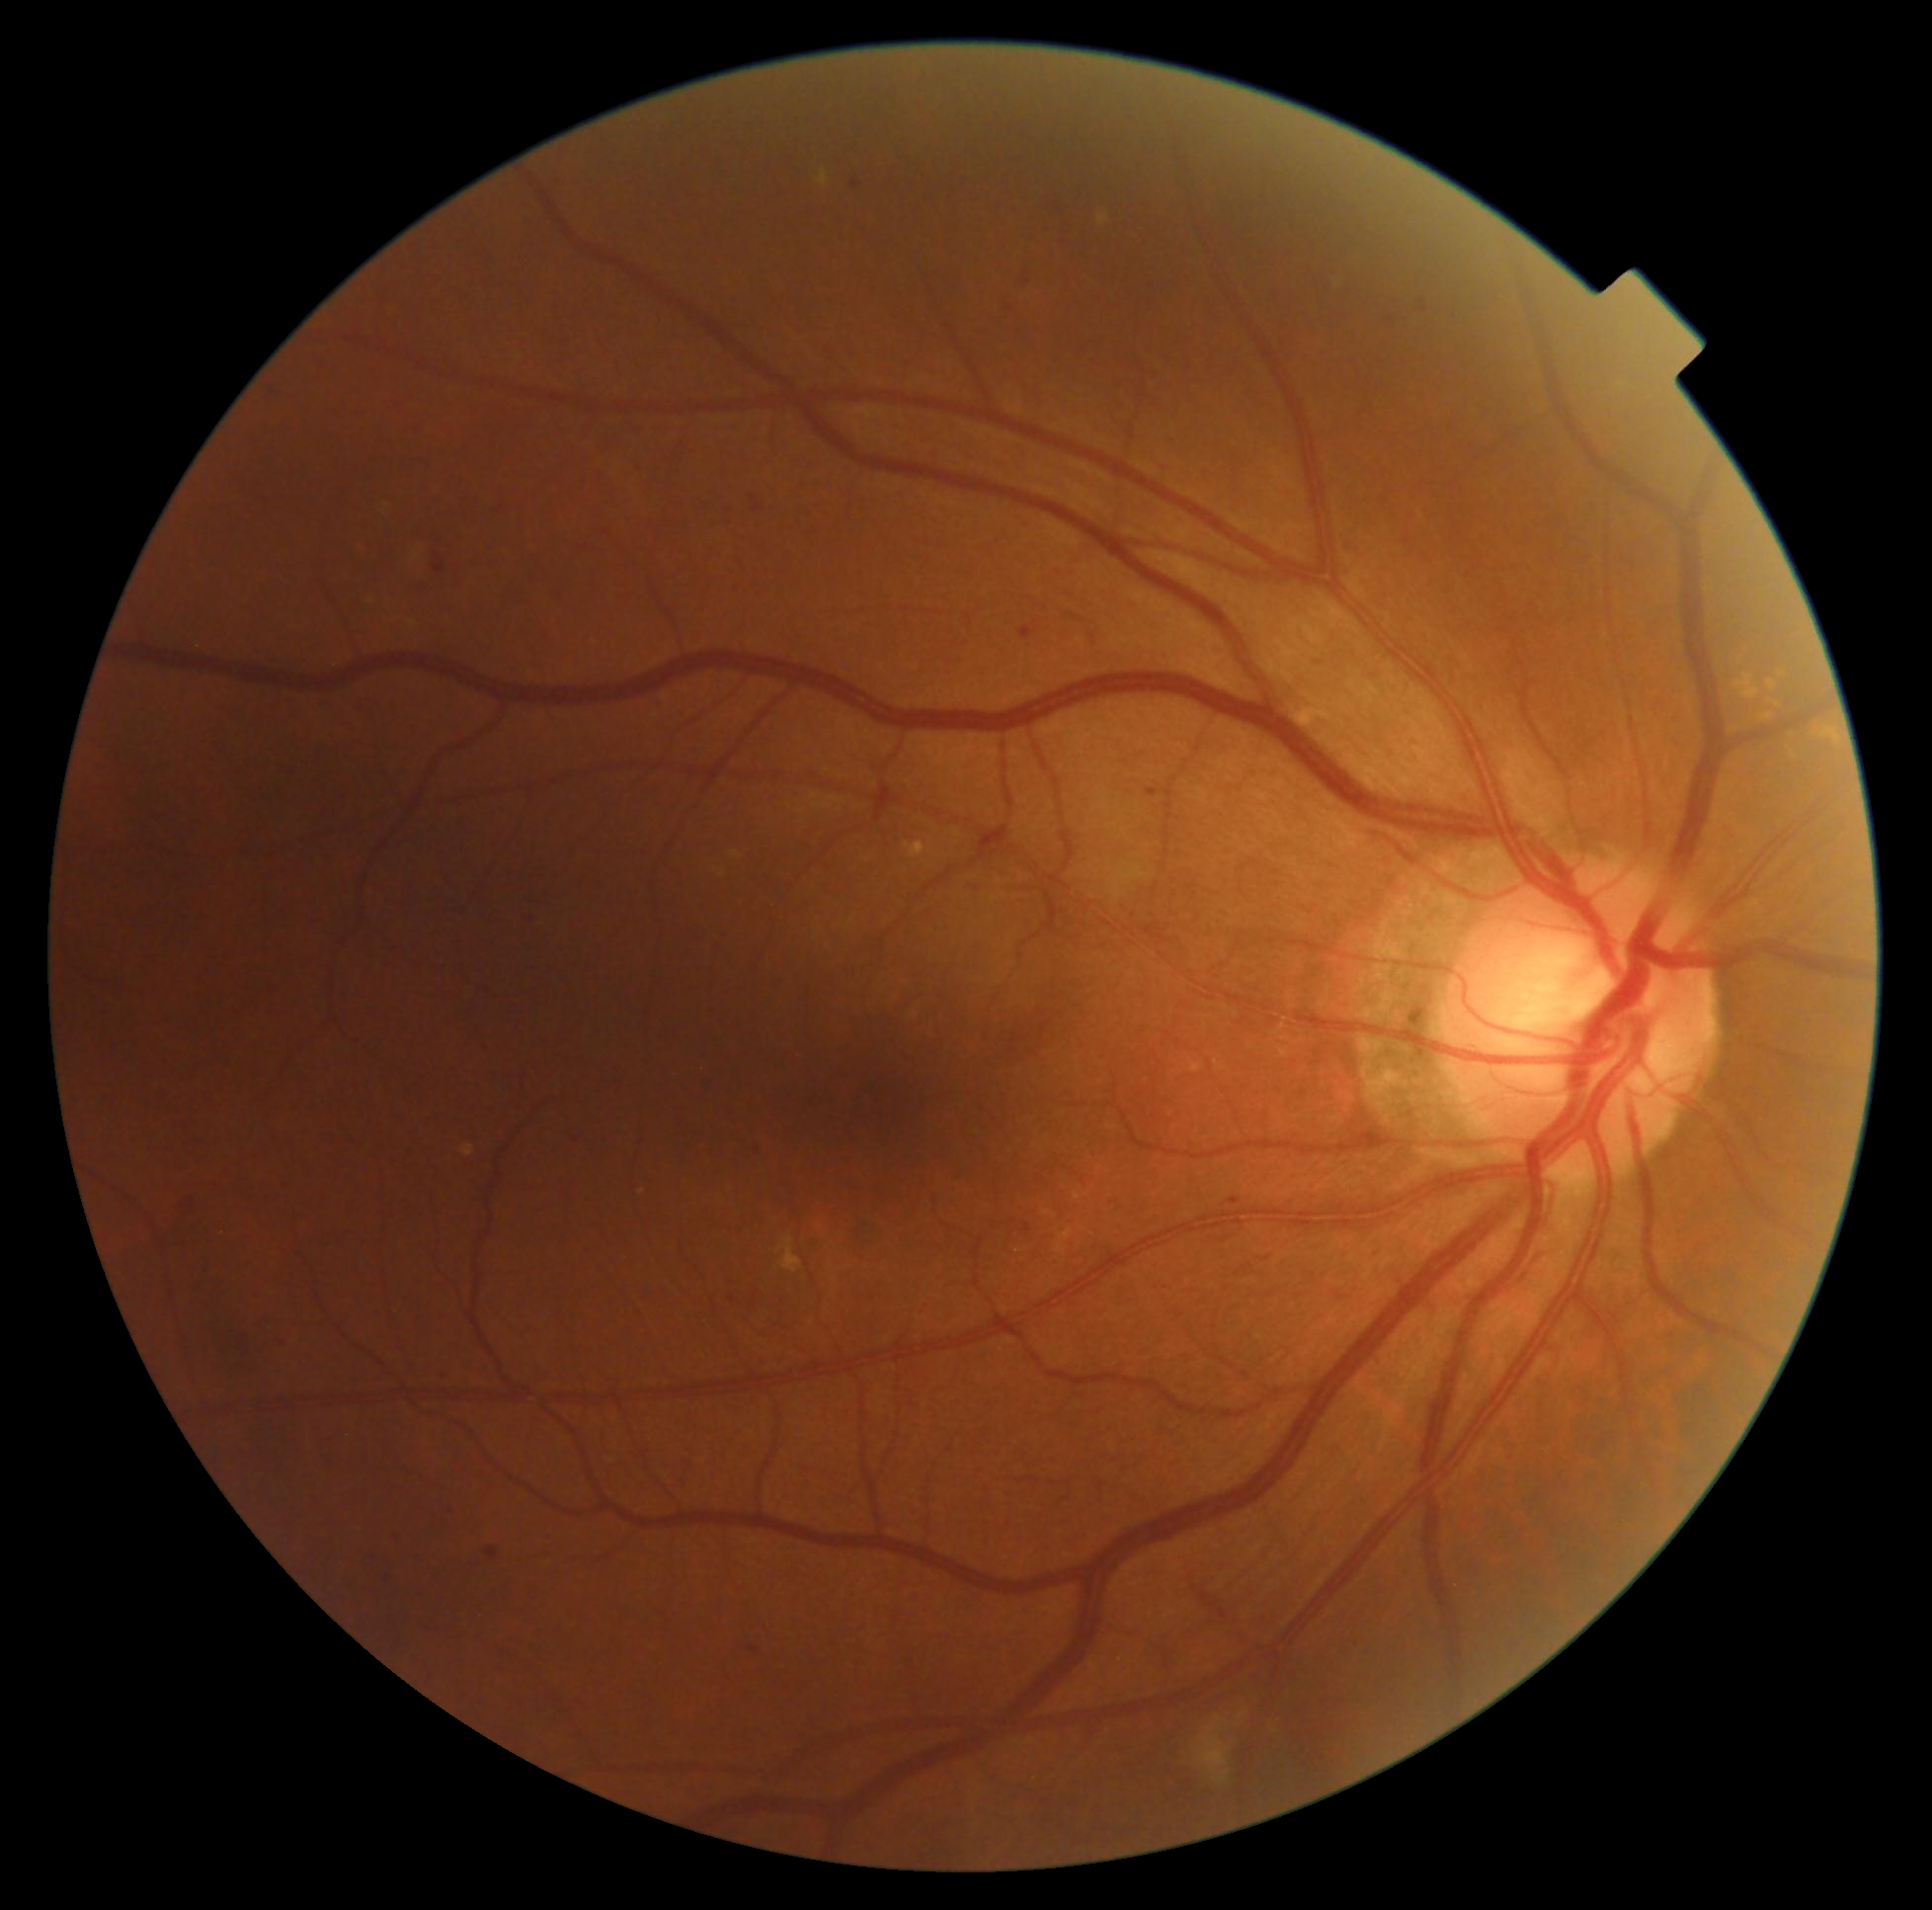 Diabetic retinopathy severity is 2.